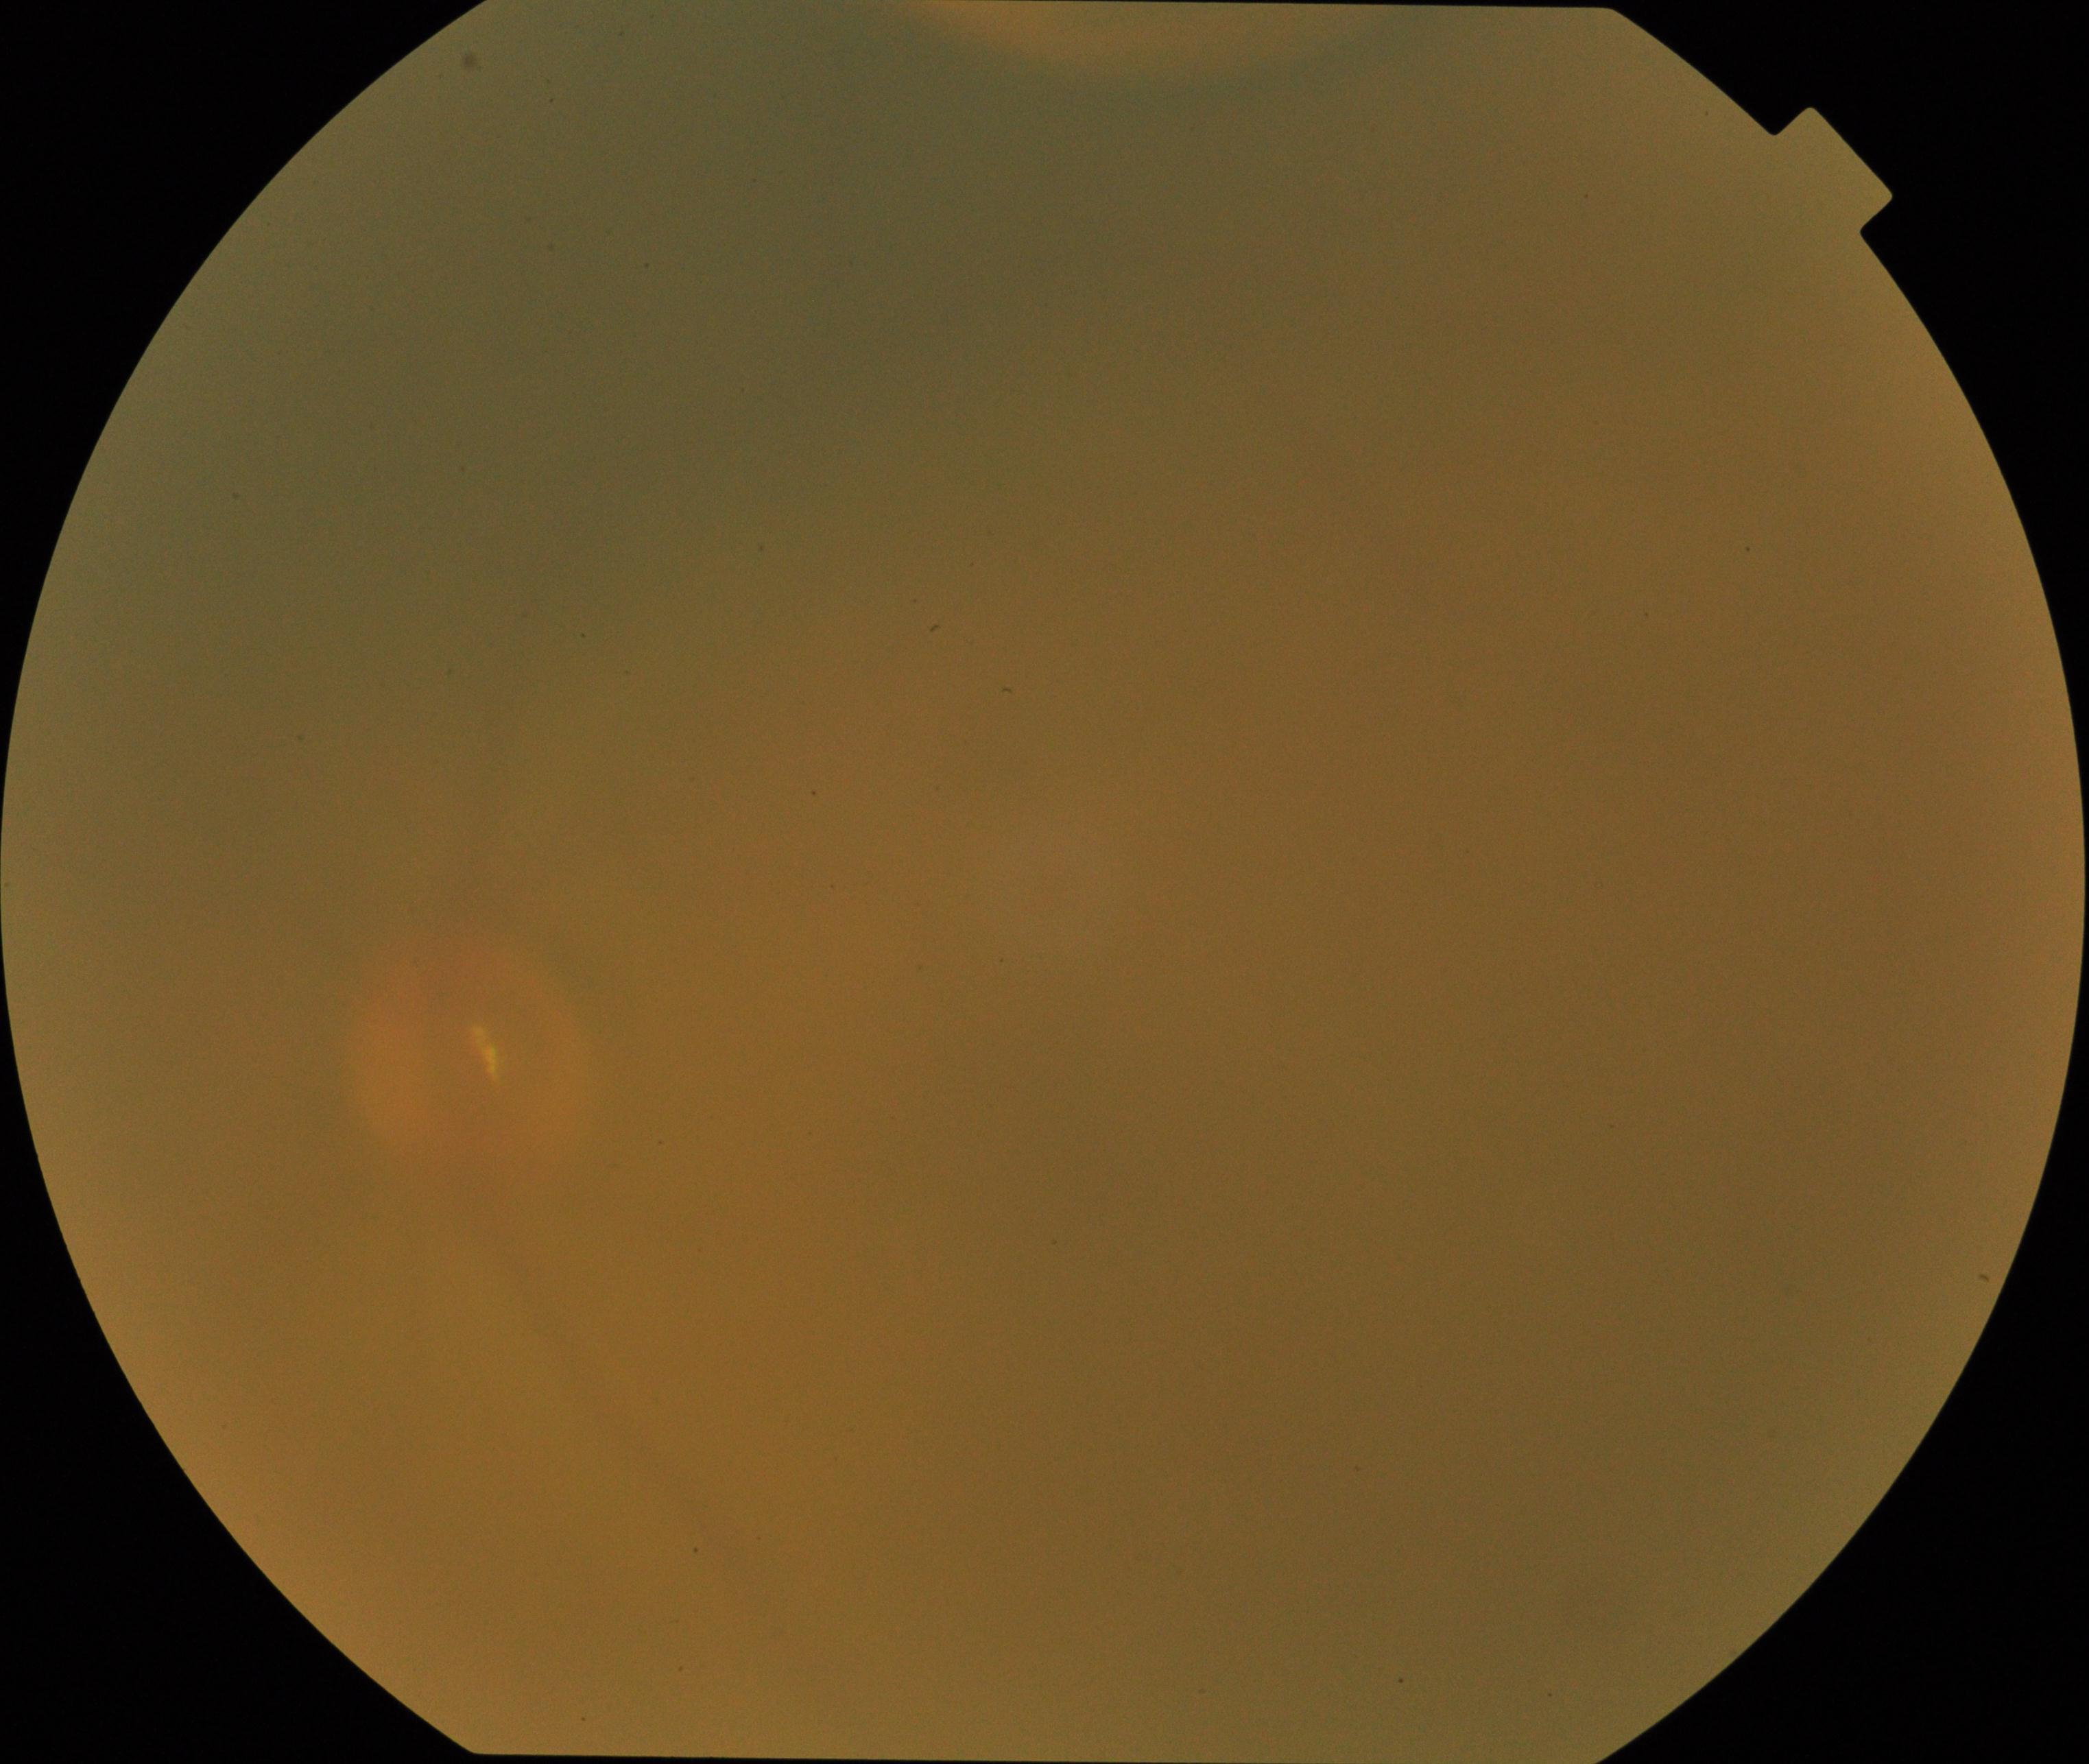 Quality: poor.
Proliferative diabetic retinopathy: not identified.